Captured on a Nidek AFC-330 fundus camera · 240 x 240 pixels · cropped to the optic nerve head:
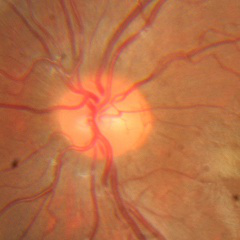 Glaucoma diagnosis: no glaucomatous optic neuropathy.